Fundus photo taken with a portable handheld camera
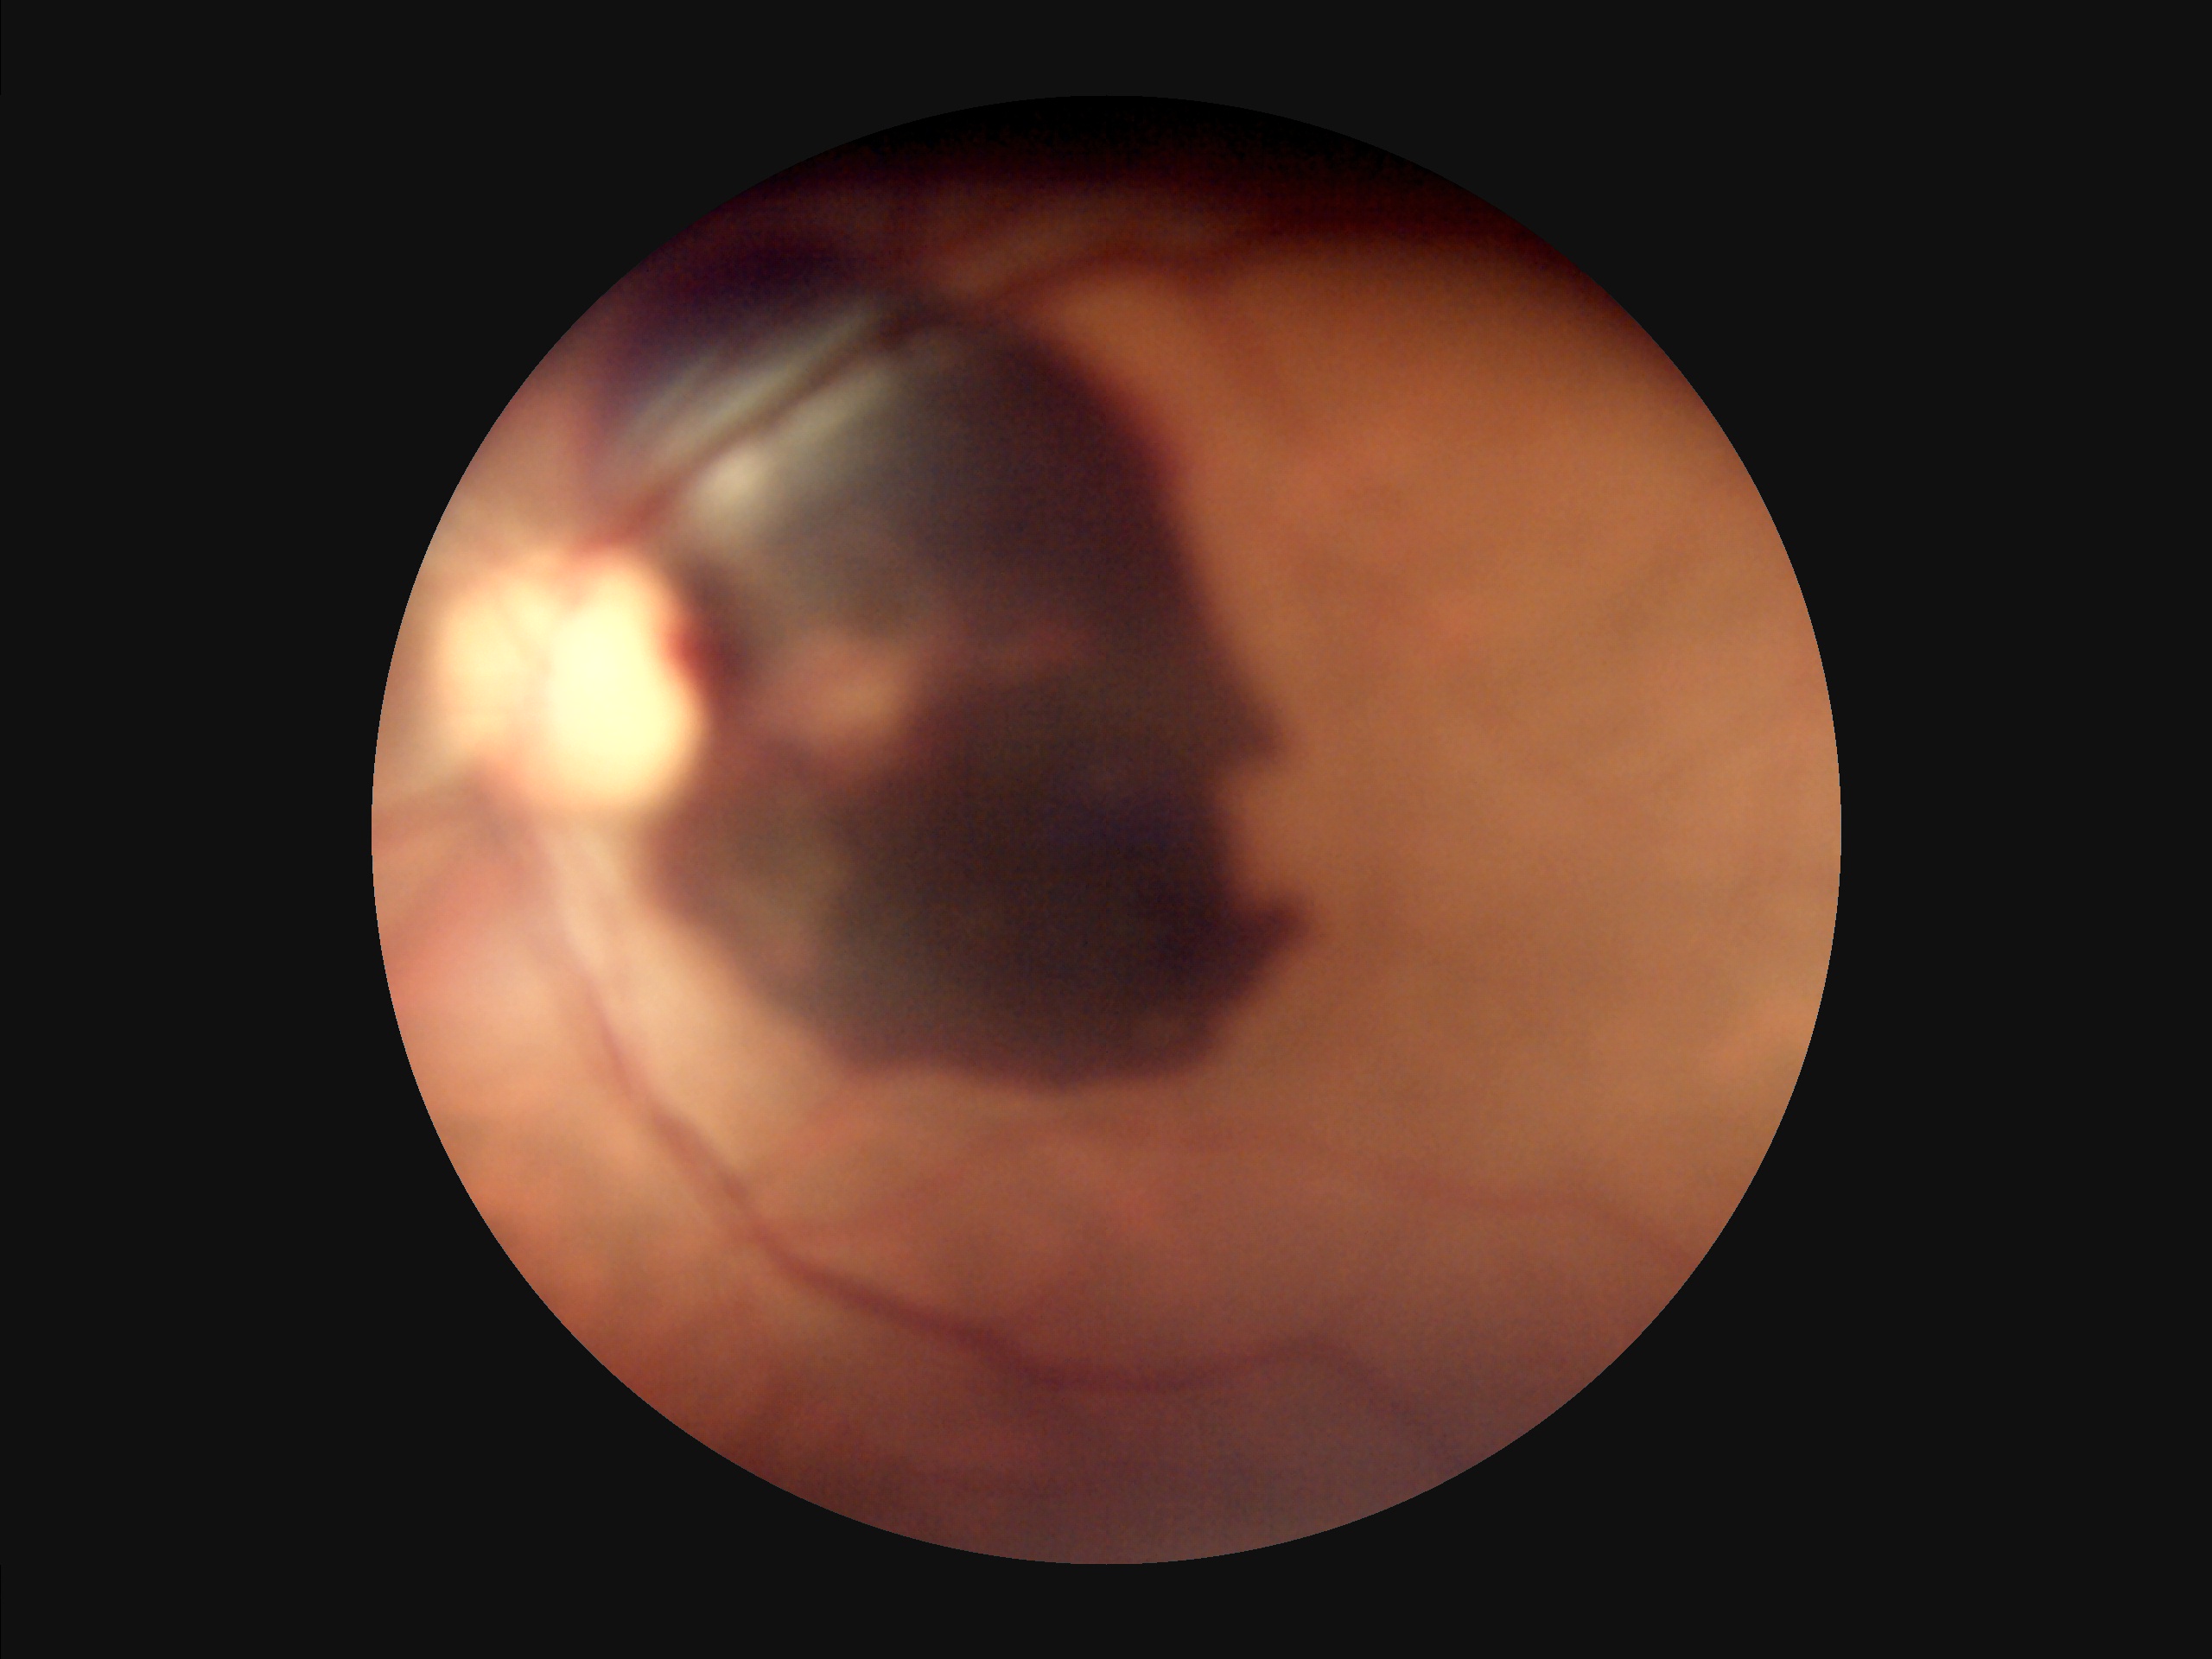
Quality grading: clarity: noticeable blur in the optic disc, vessels, or background | overall: poor, ungradable | contrast: poor dynamic range | illumination/color: over- or under-exposed.